Modified Davis classification · camera: NIDEK AFC-230 · 45-degree field of view: 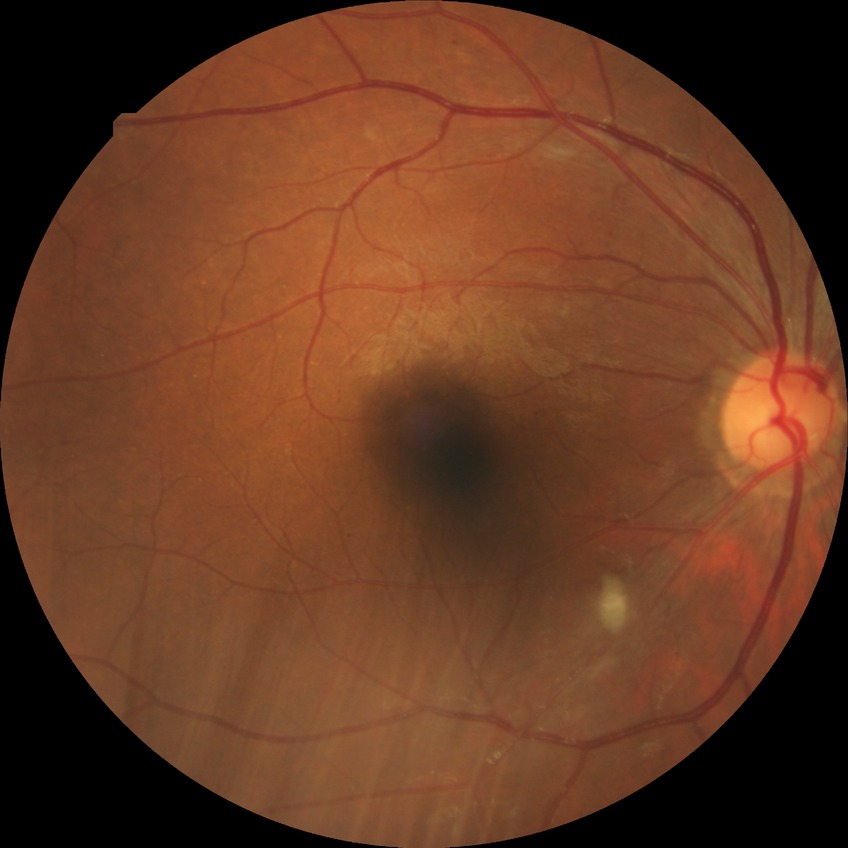

modified Davis grade: SDR.